NIDEK AFC-230; 45 degree fundus photograph; no pharmacologic dilation — 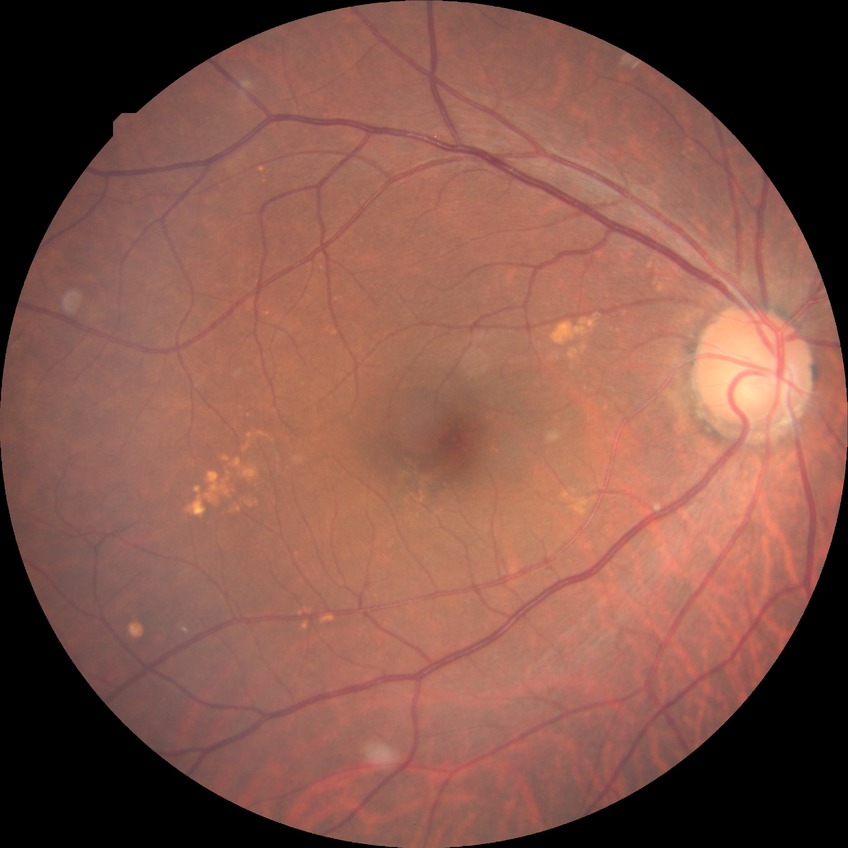
  davis_grade: no diabetic retinopathy (NDR)